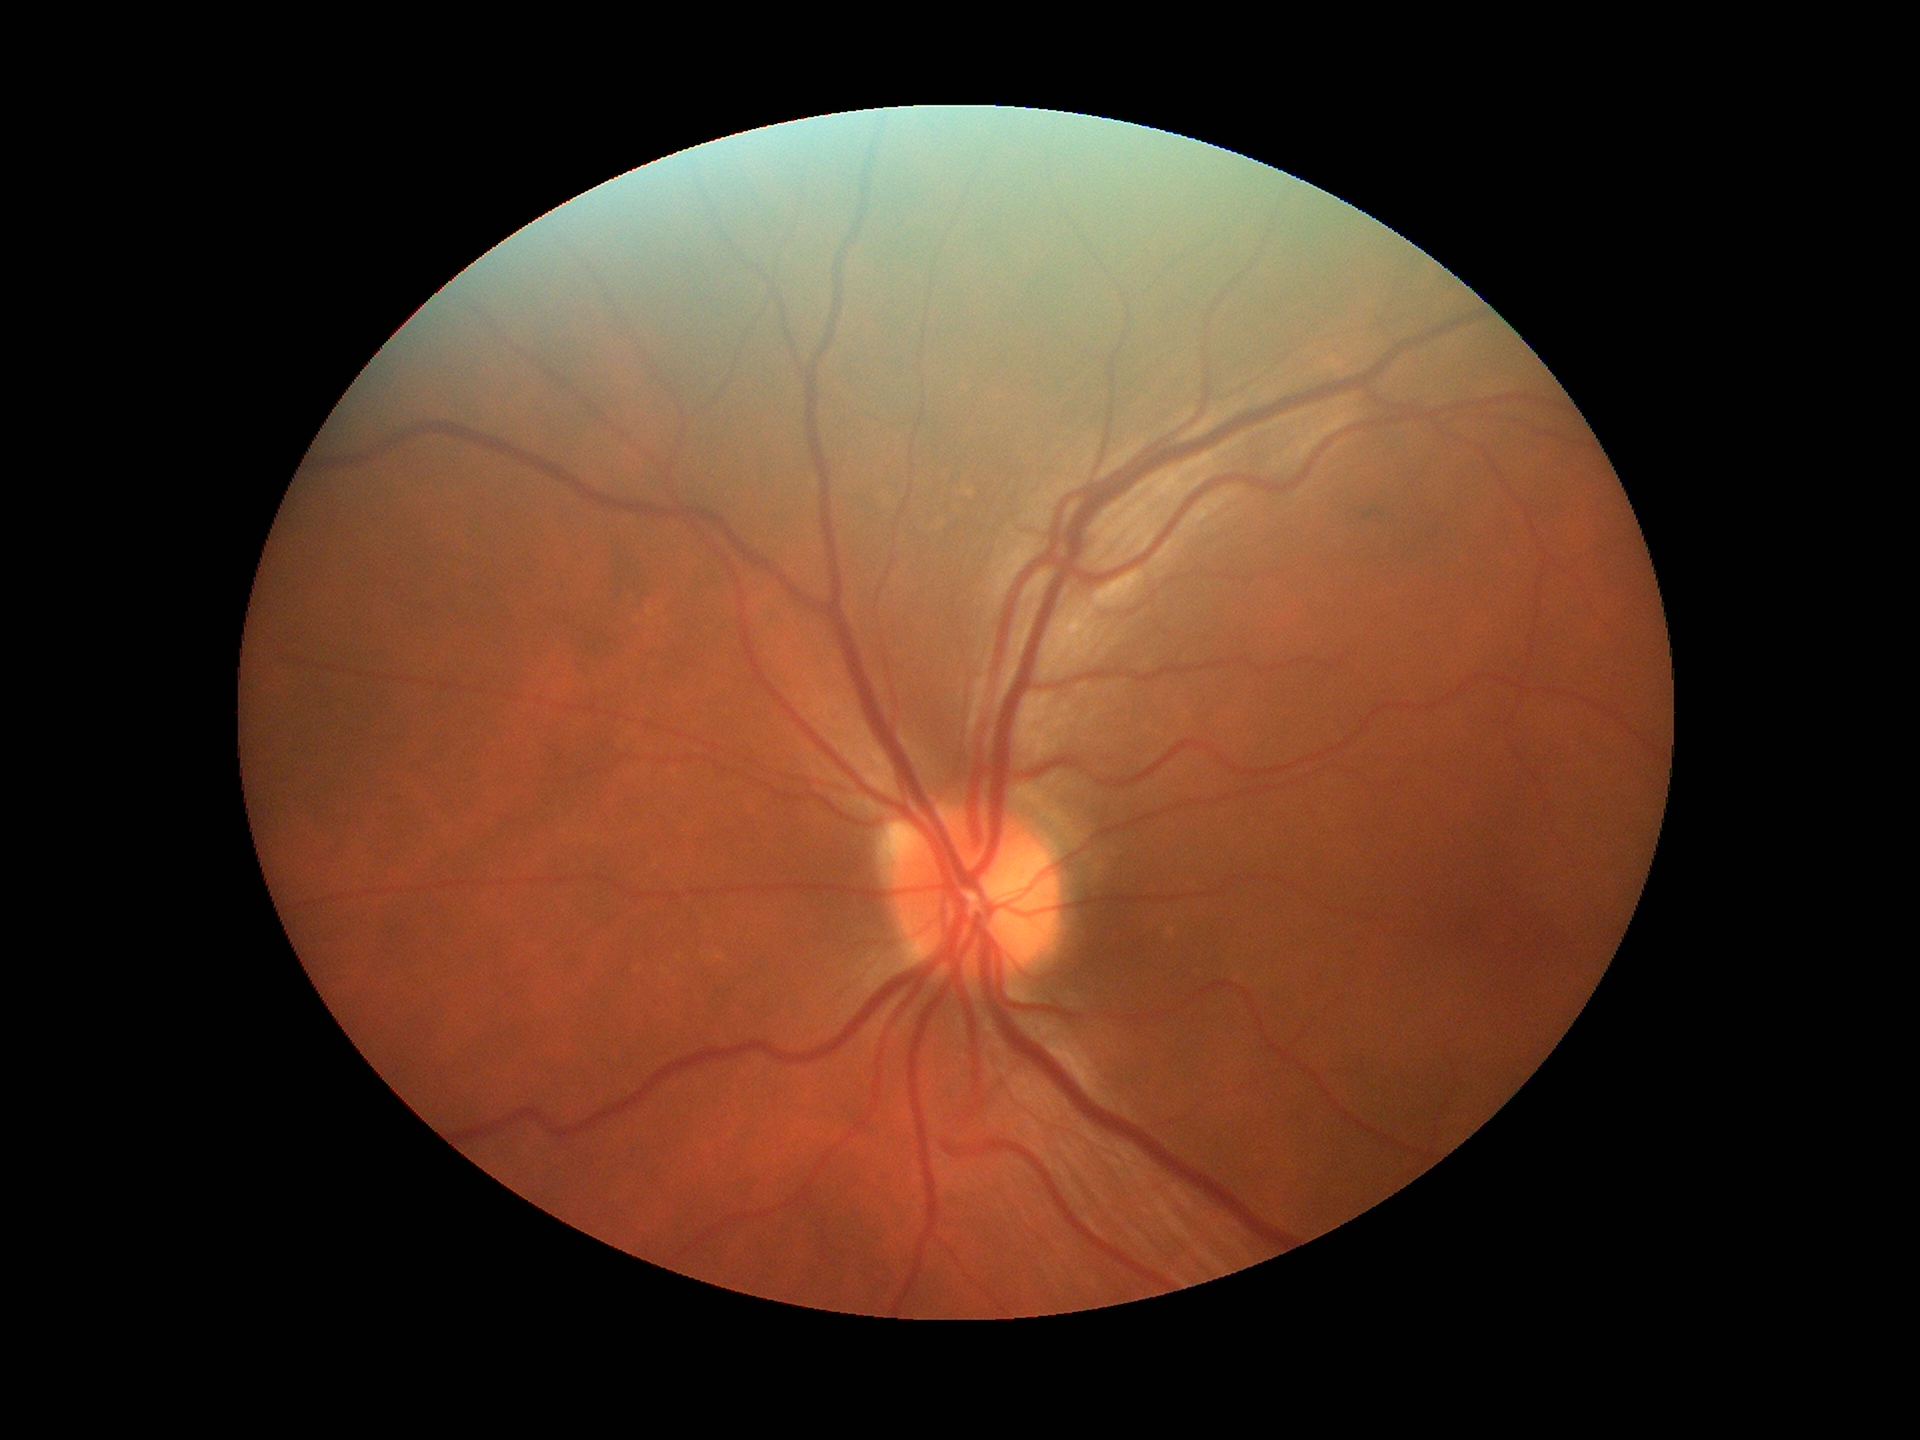 Not suspicious for glaucoma. VCDR: 0.41.